2212 x 1659 pixels, 45° field of view, fundus photo: 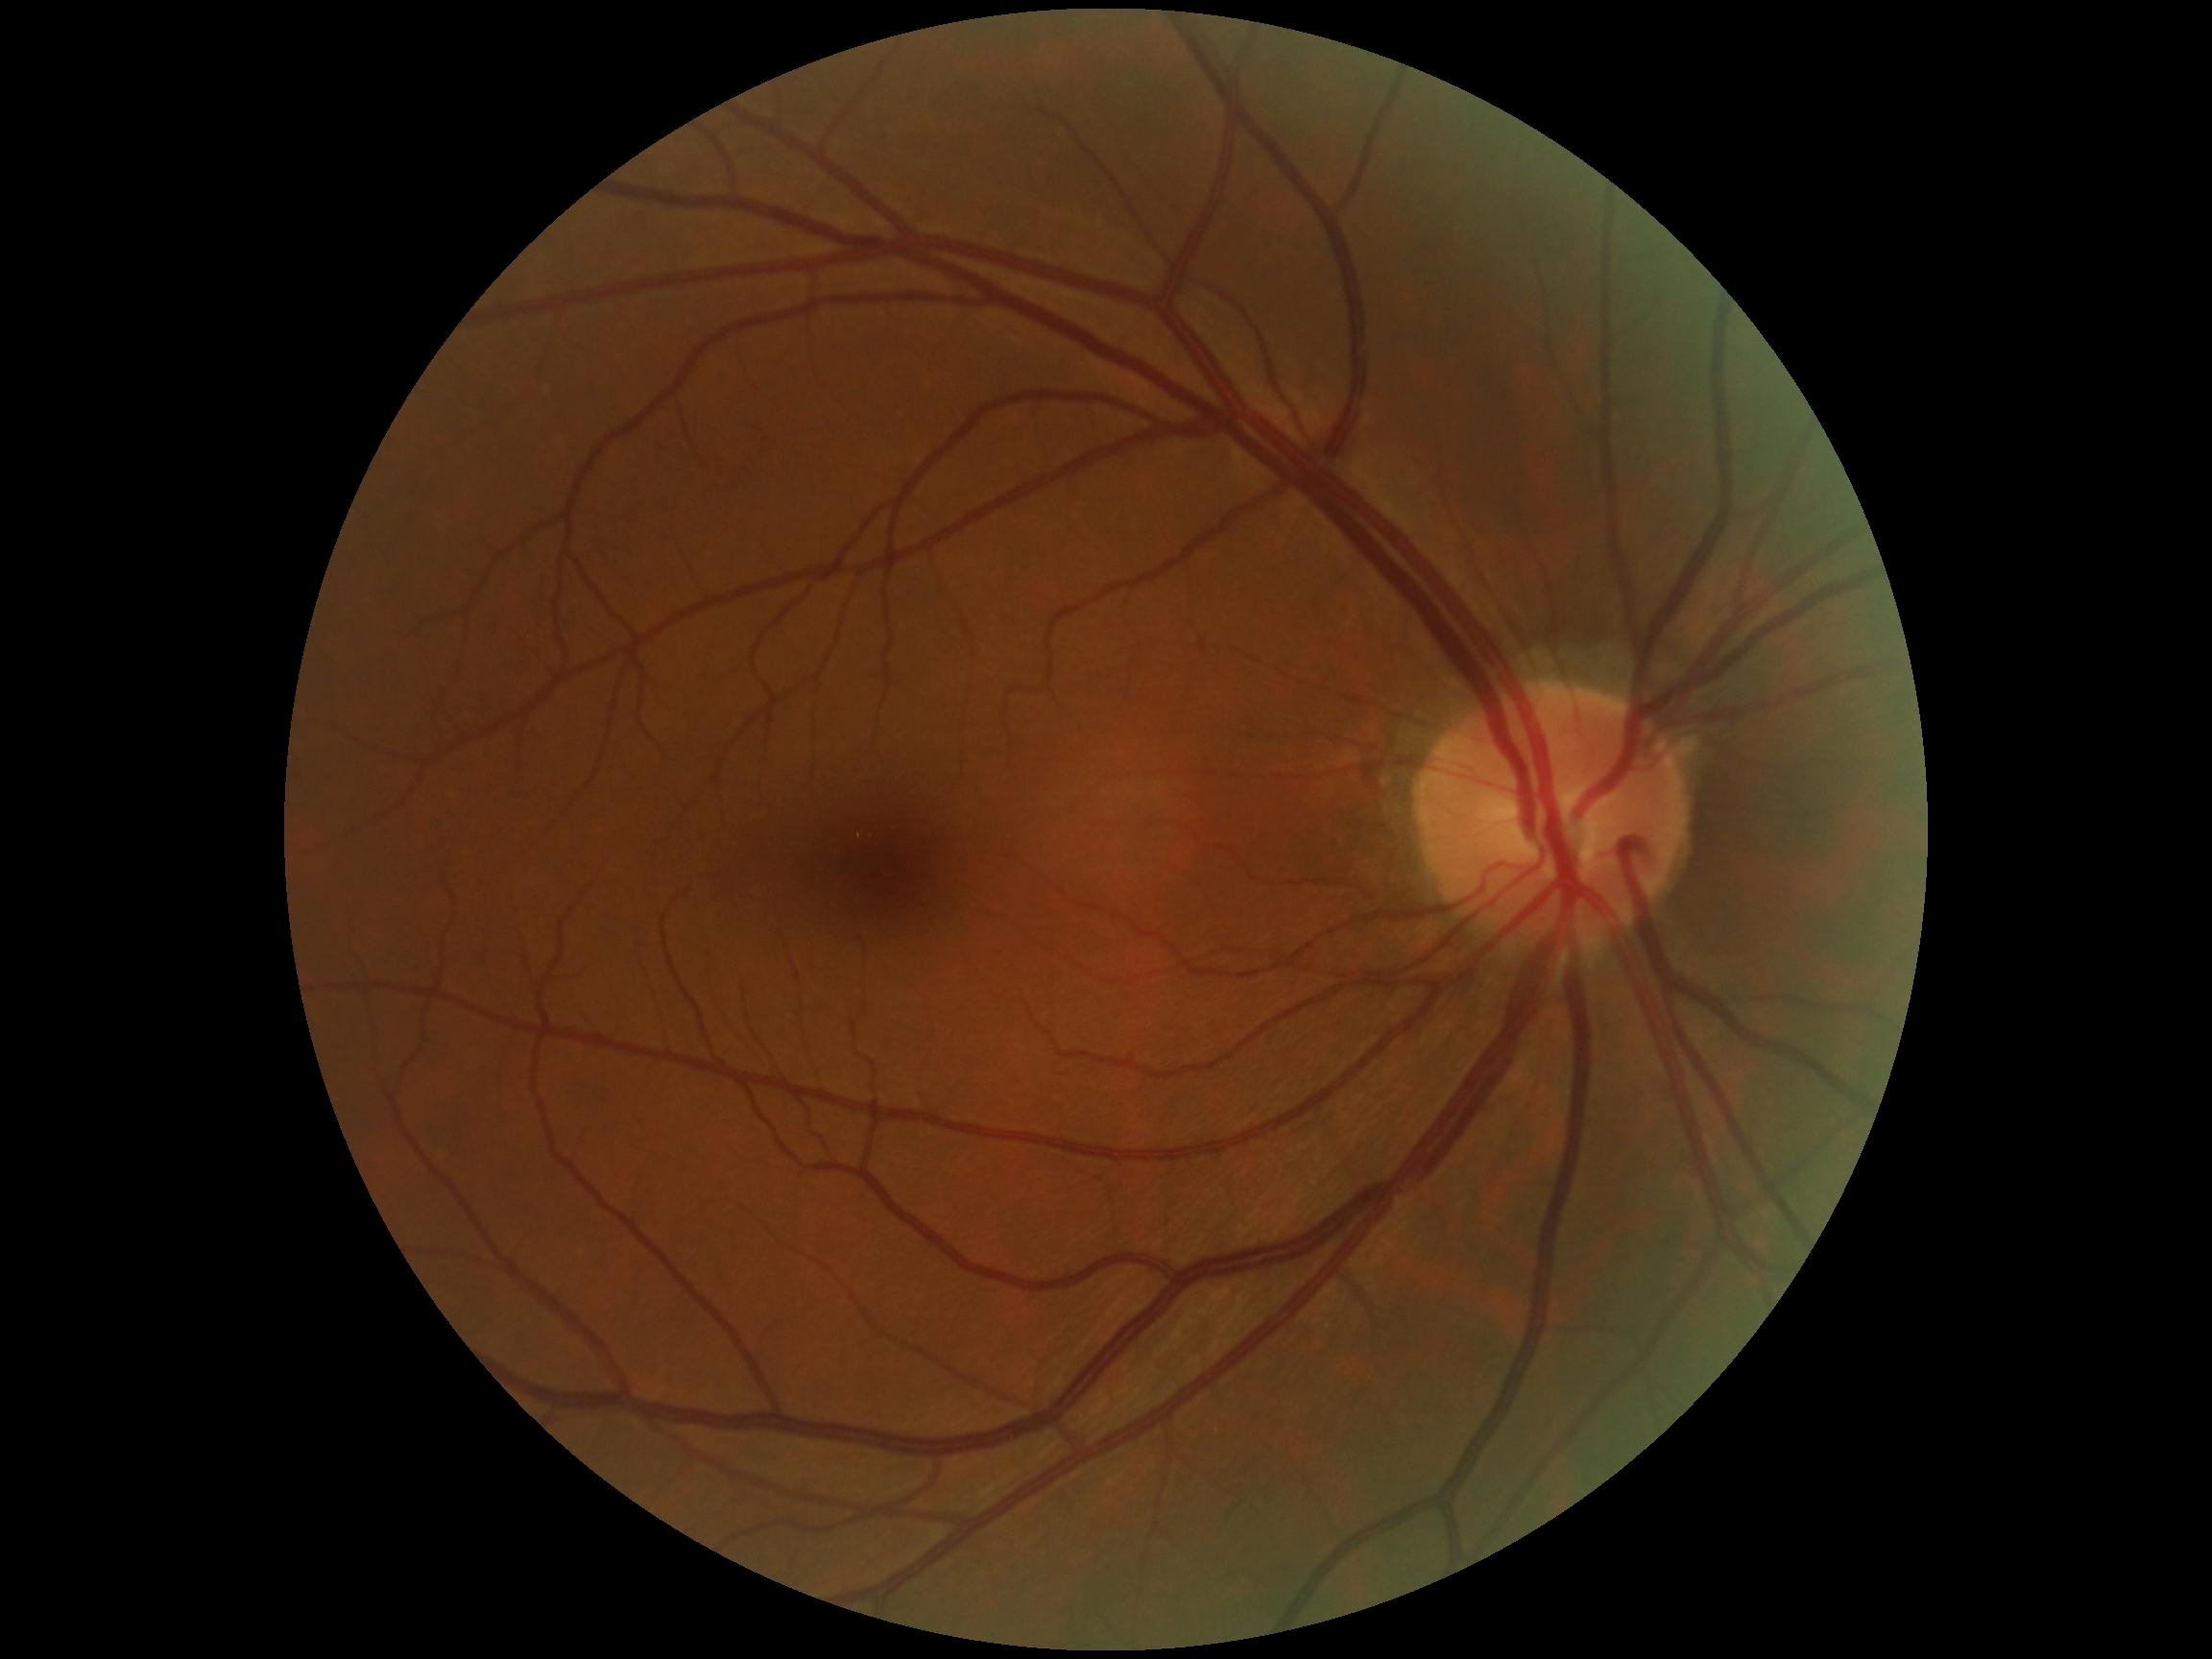 DR stage is grade 0 (no apparent retinopathy).